Acquired with a NIDEK AFC-230 · modified Davis grading · nonmydriatic fundus photograph · 848x848:
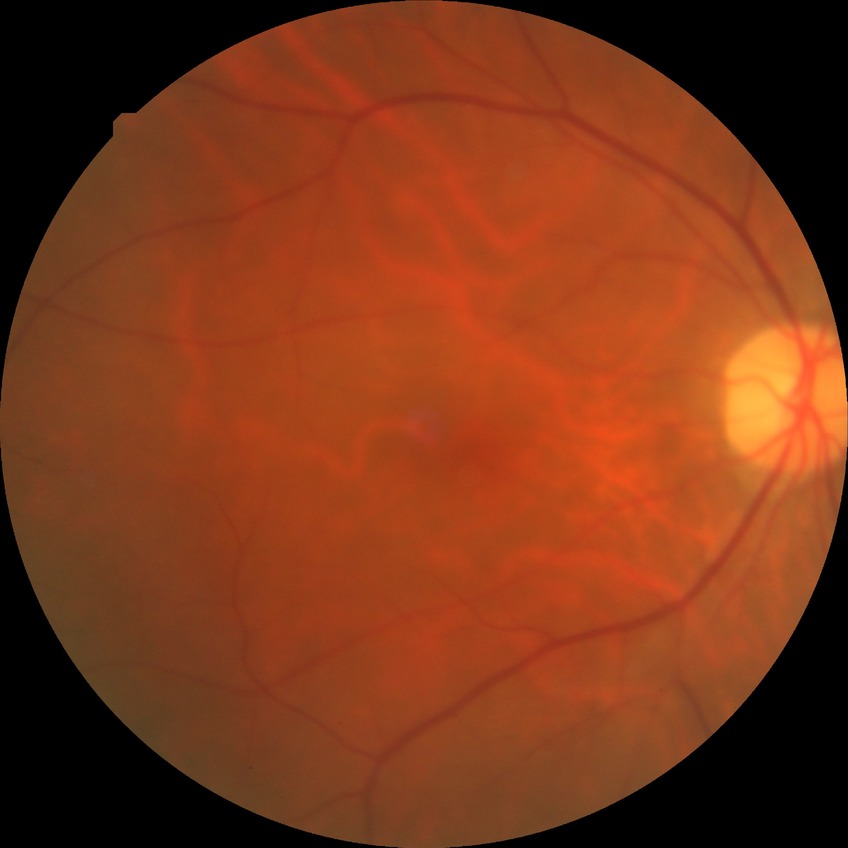
Diabetic retinopathy (DR): NDR (no diabetic retinopathy).